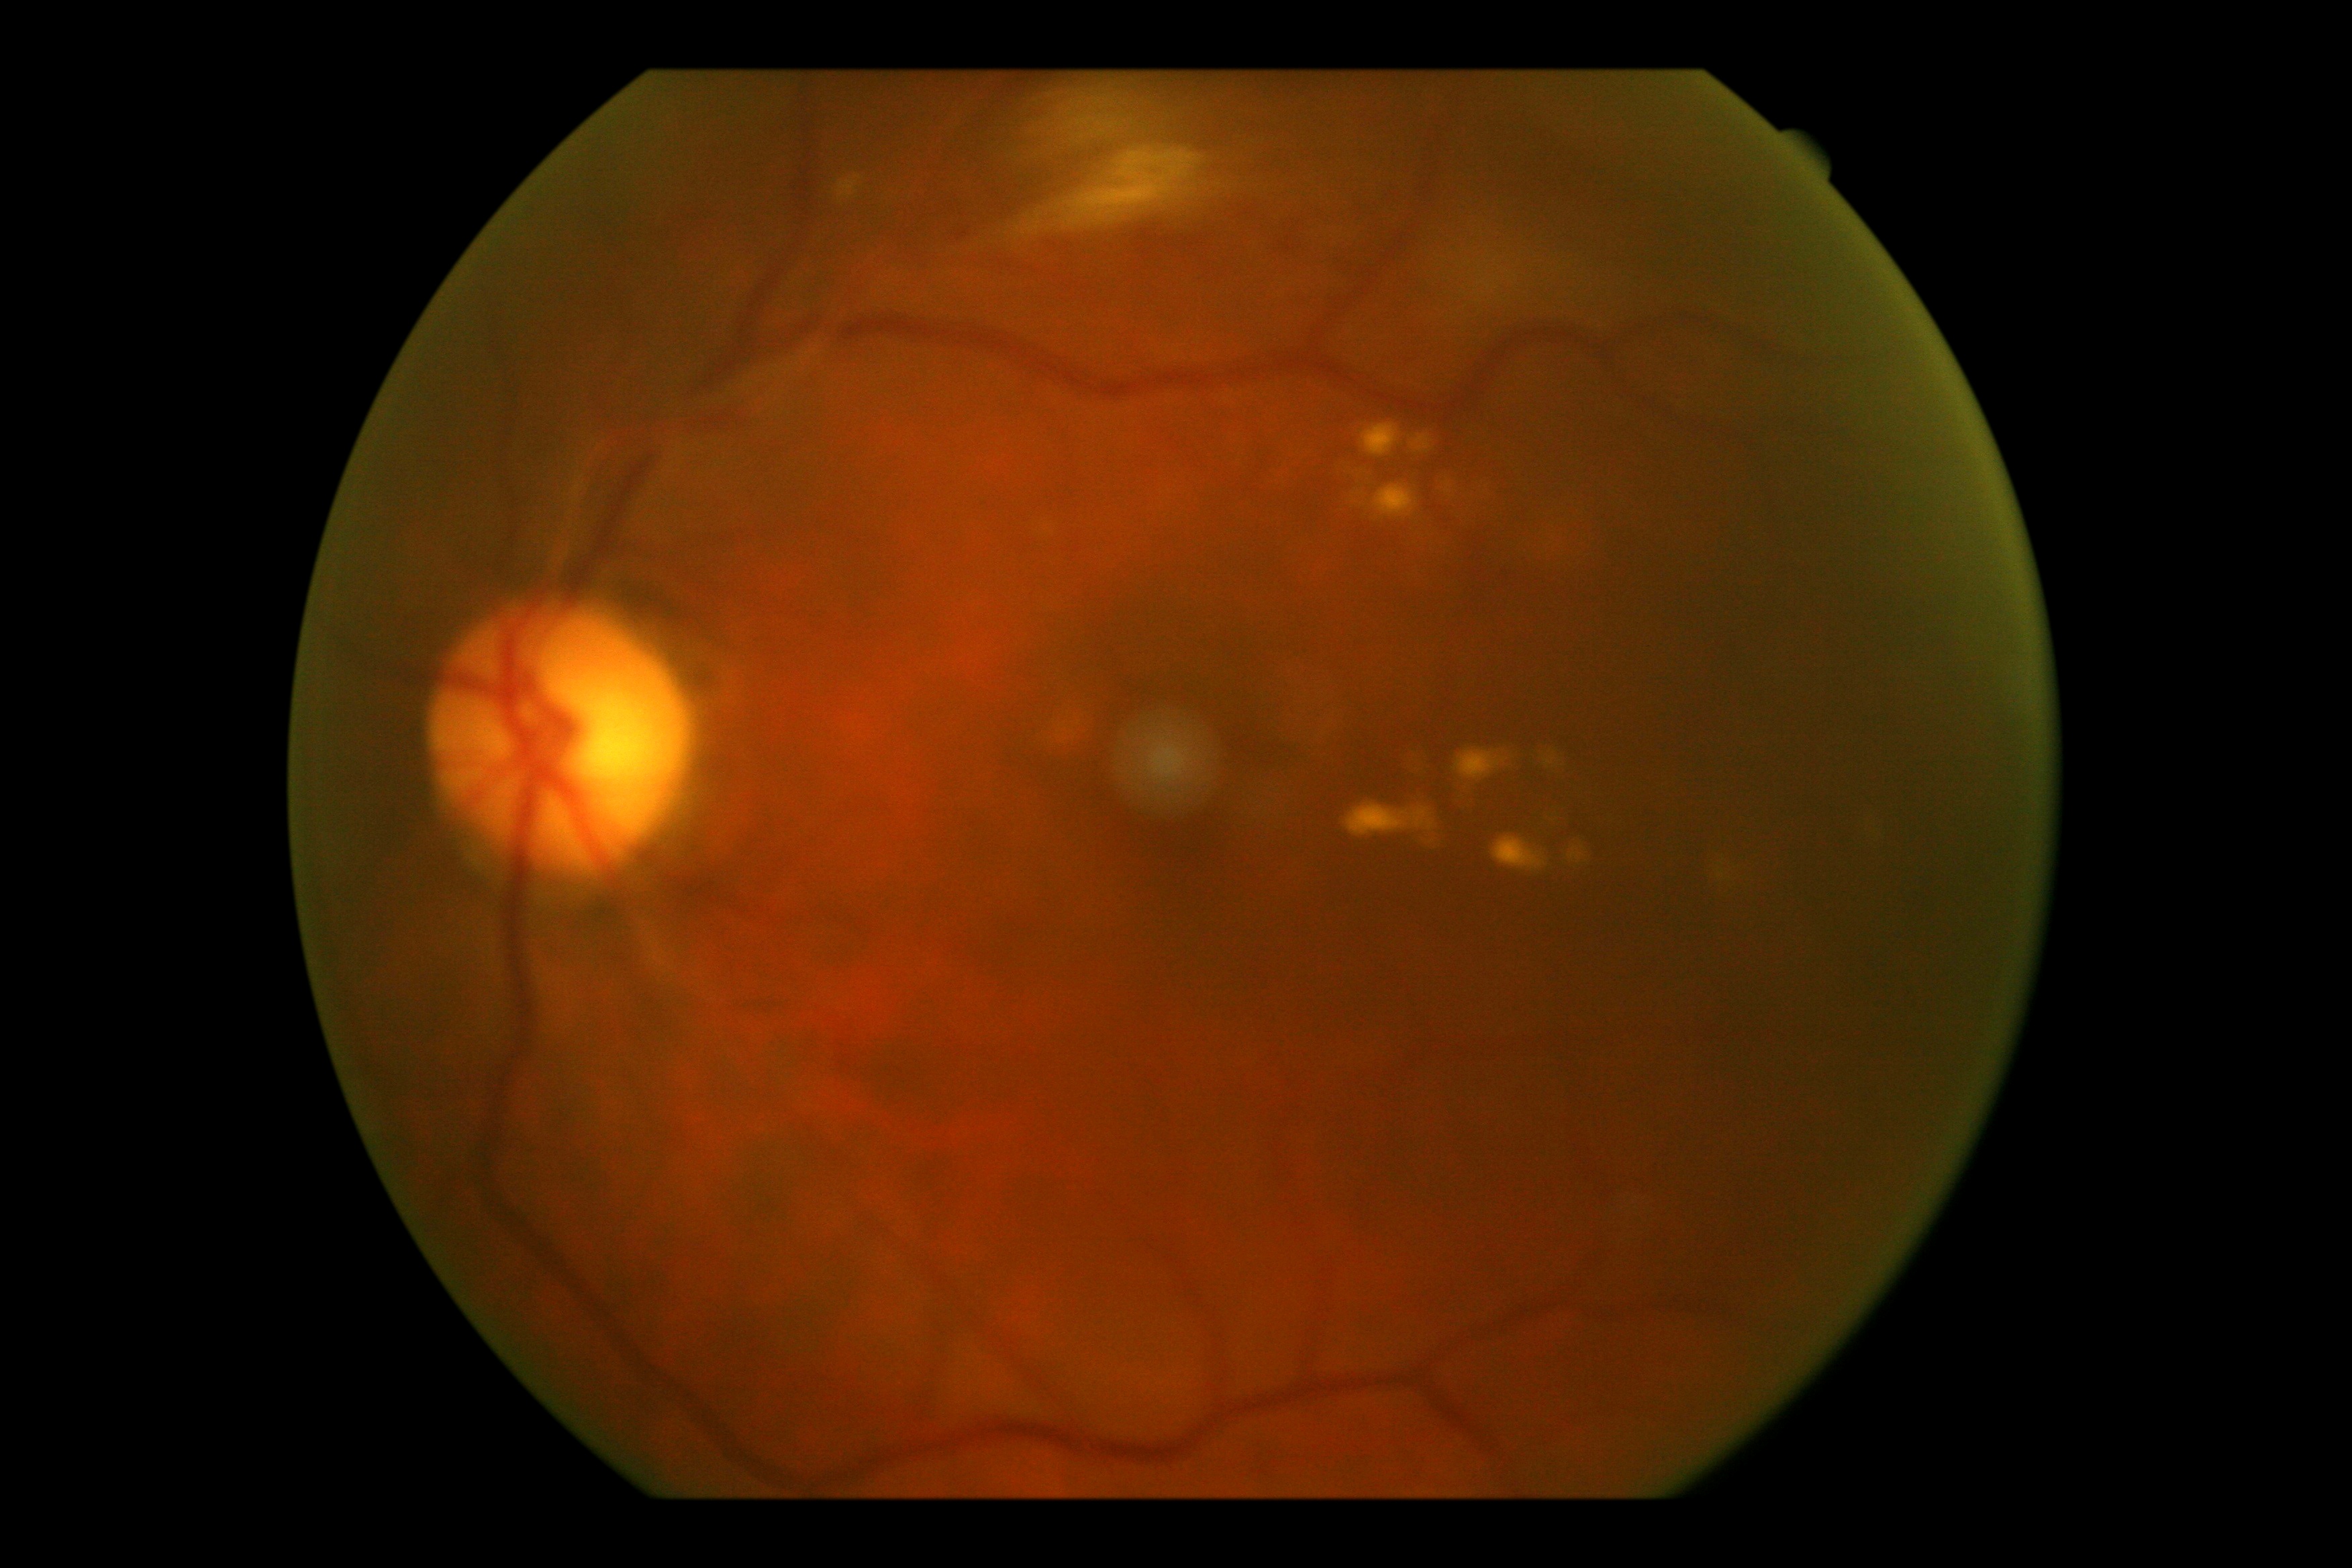

DR is 2.